Camera: Nidek AFC-330
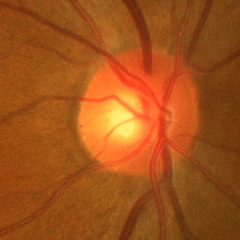 Findings consistent with early glaucomatous optic neuropathy.